848x848px; 45° field of view; without pupil dilation:
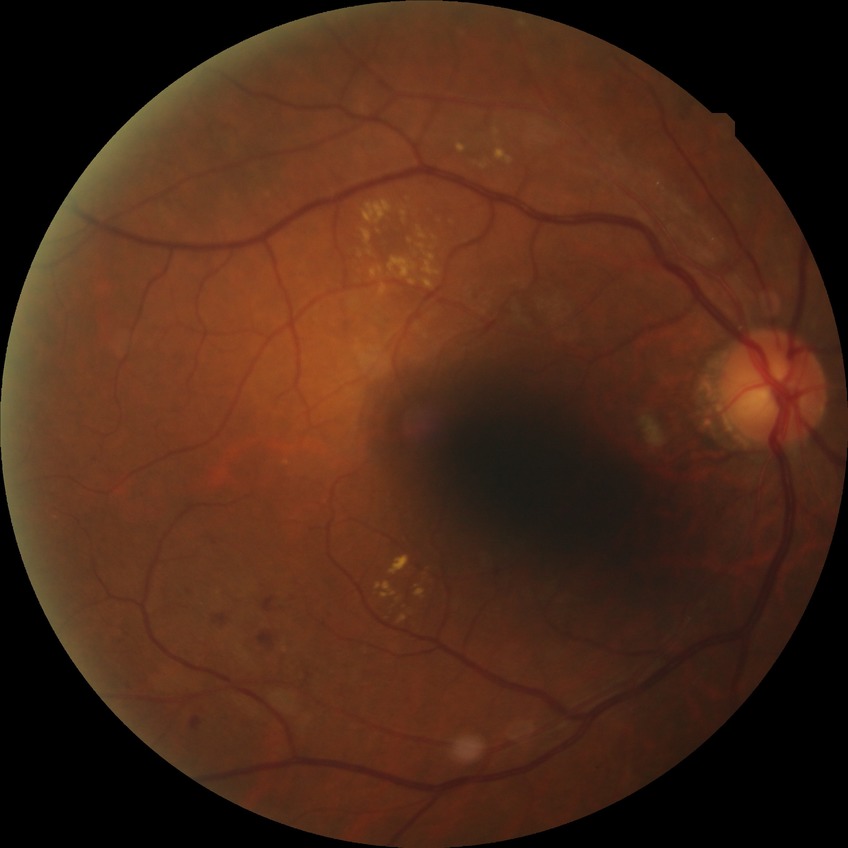

Davis grading=pre-proliferative diabetic retinopathy.